2361 x 1568 pixels:
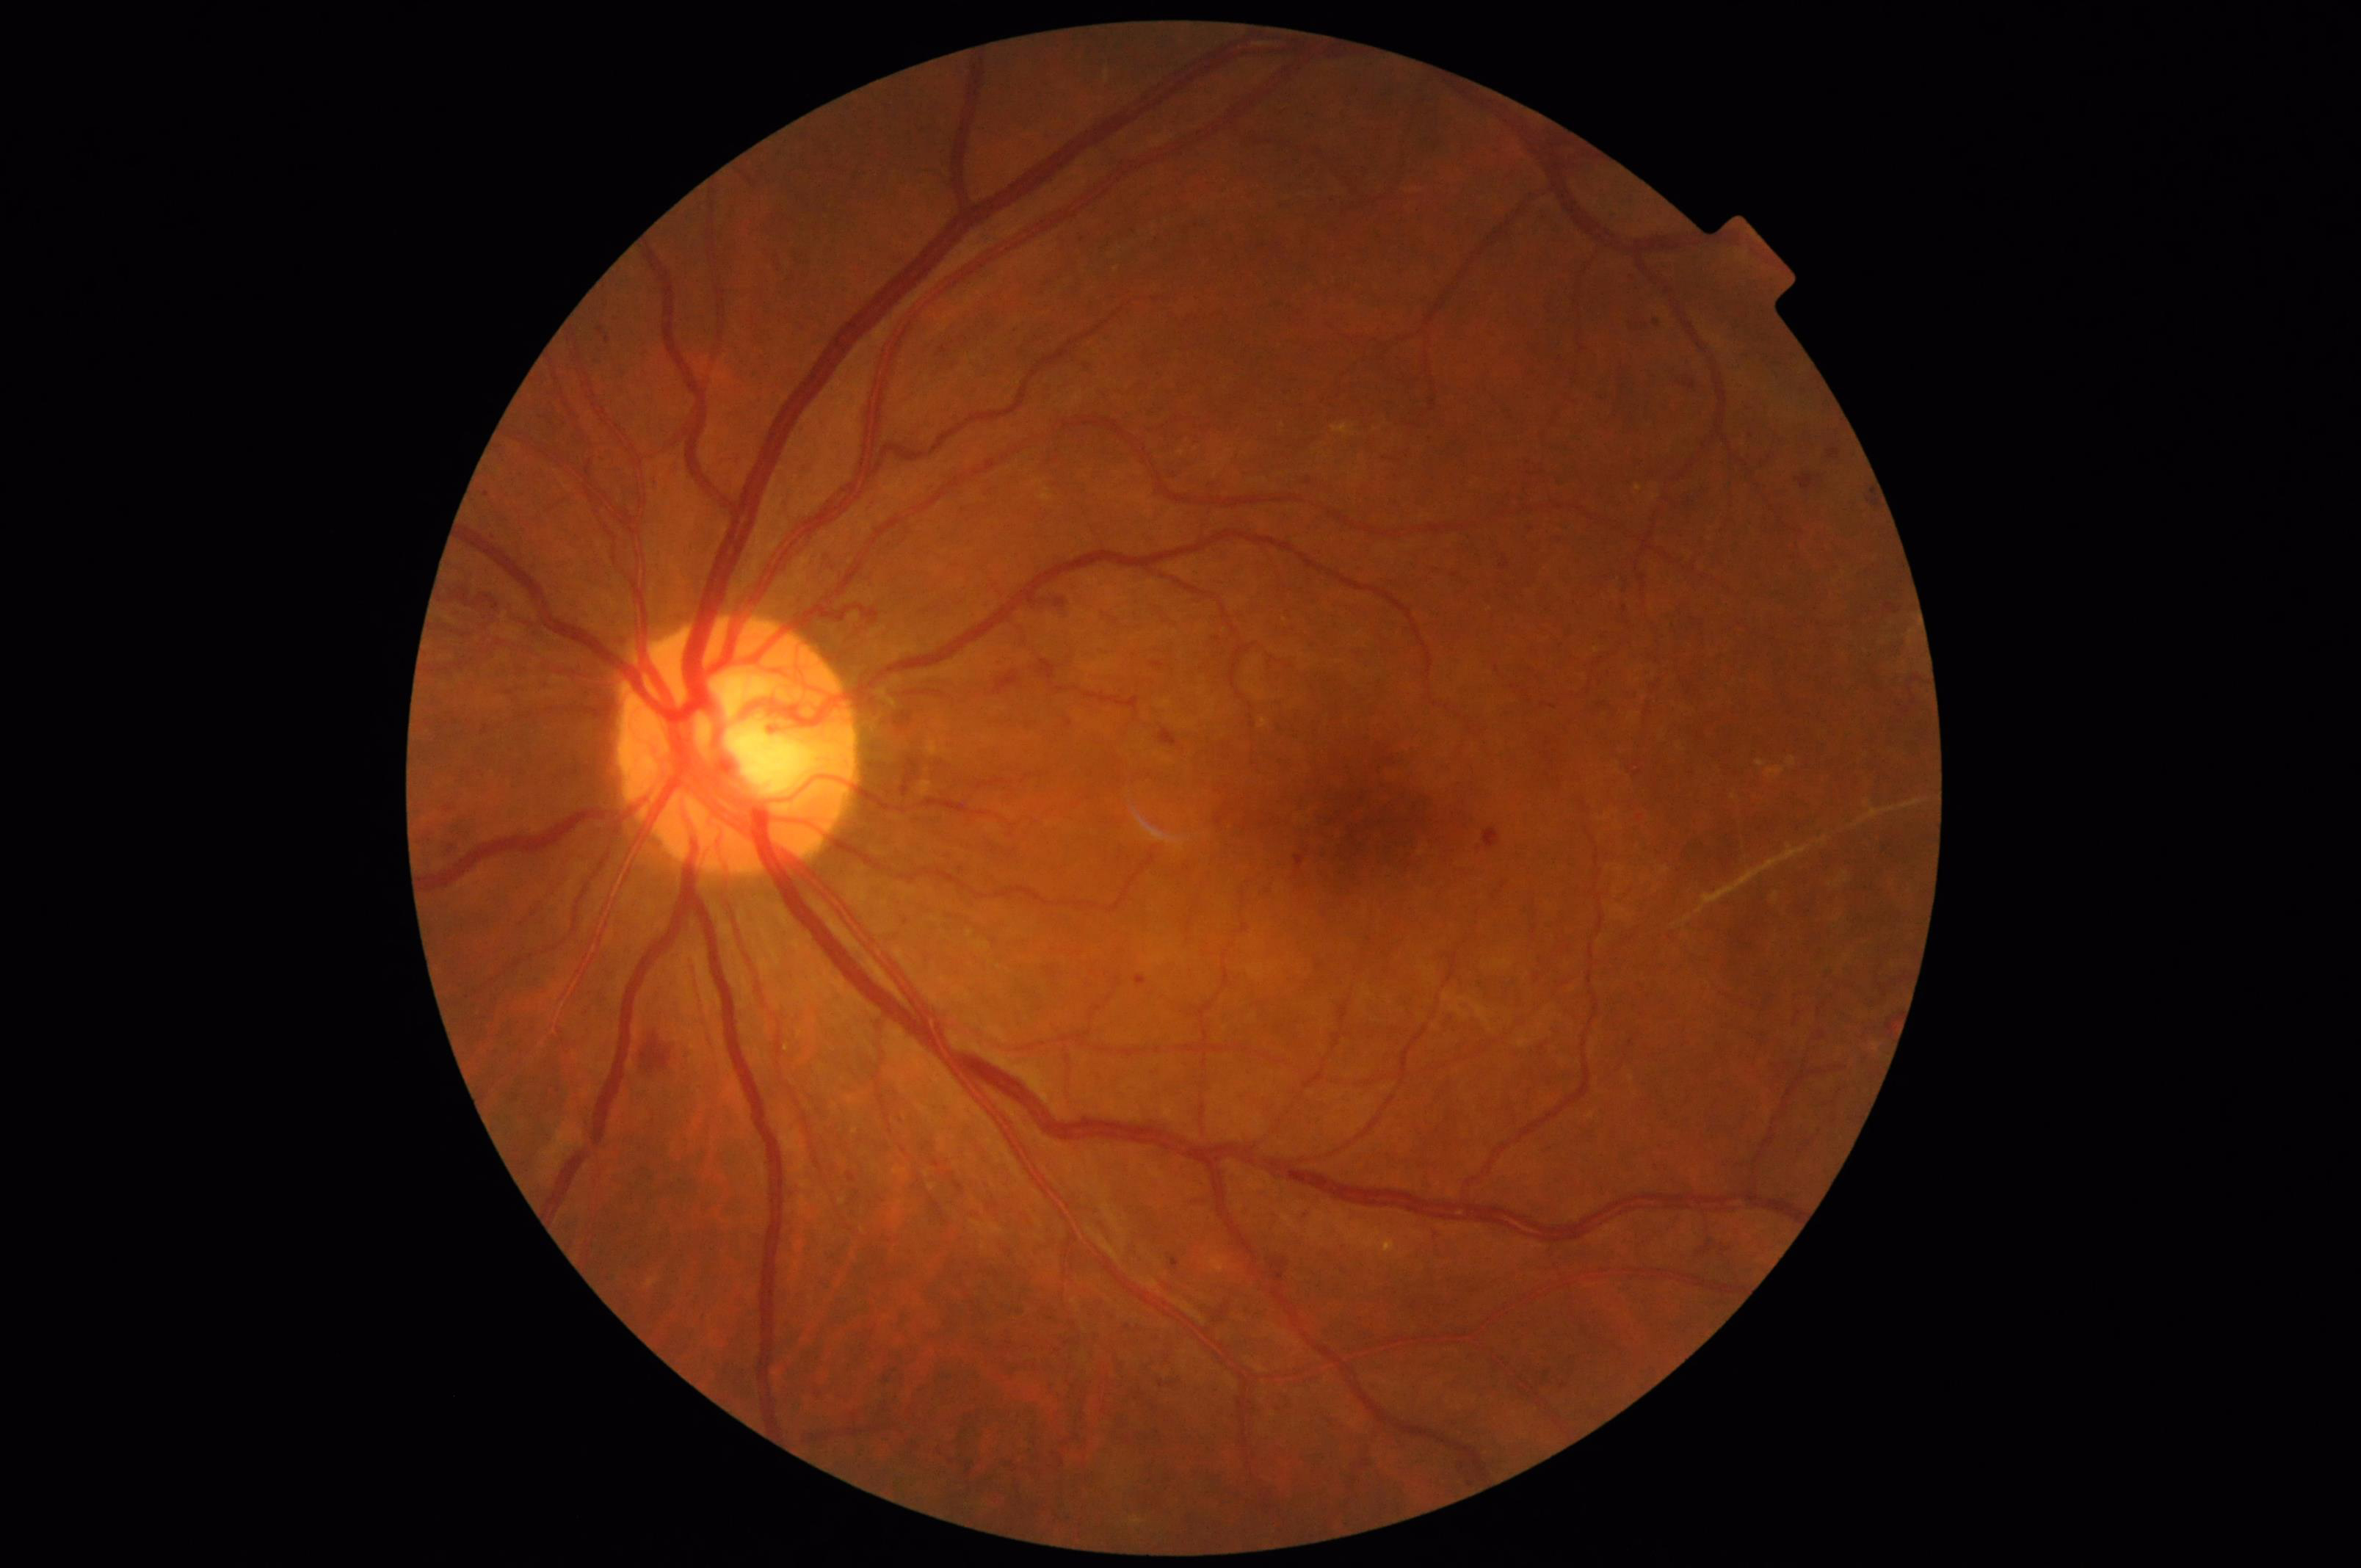
illumination: good
contrast: satisfactory
overall_quality: adequate
clarity: good